Acquired with a Remidio Fundus on Phone (FOP) camera. 1659x2212px: 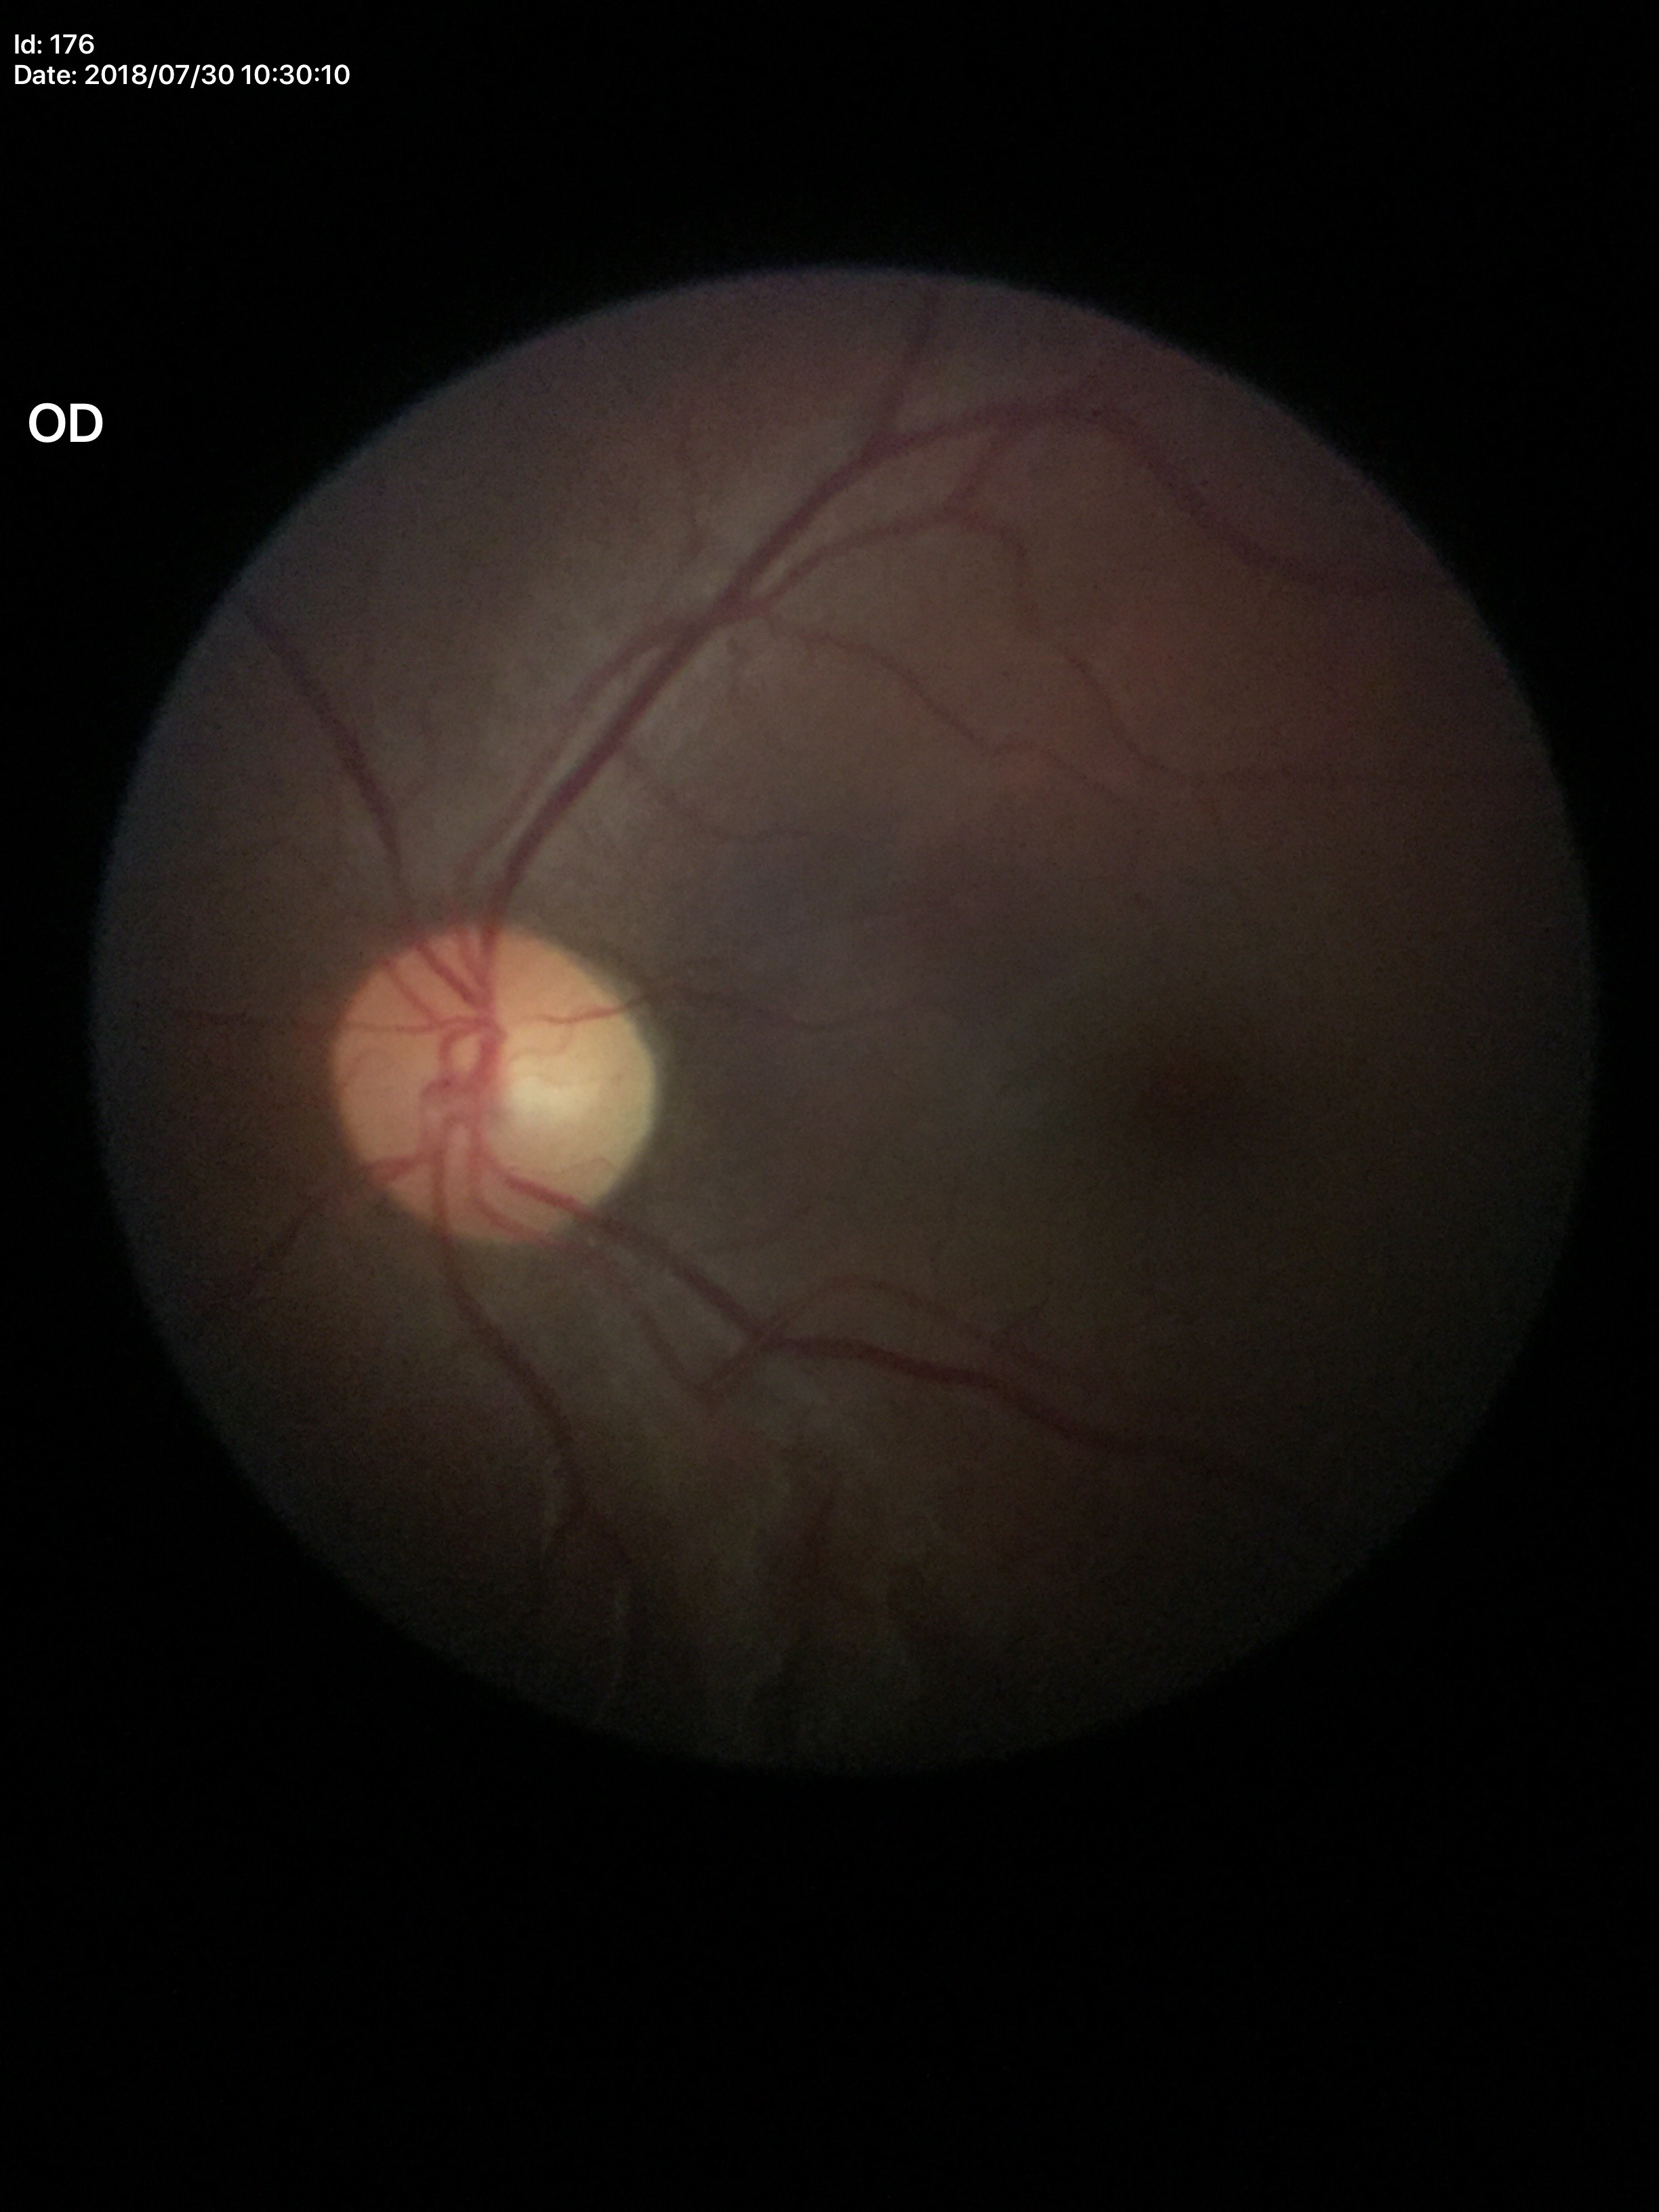
horizontal cup-disc ratio (HCDR): 0.52, vertical cup-to-disc ratio (VCDR): 0.49, Glaucoma impression: not suspect.